CFP: 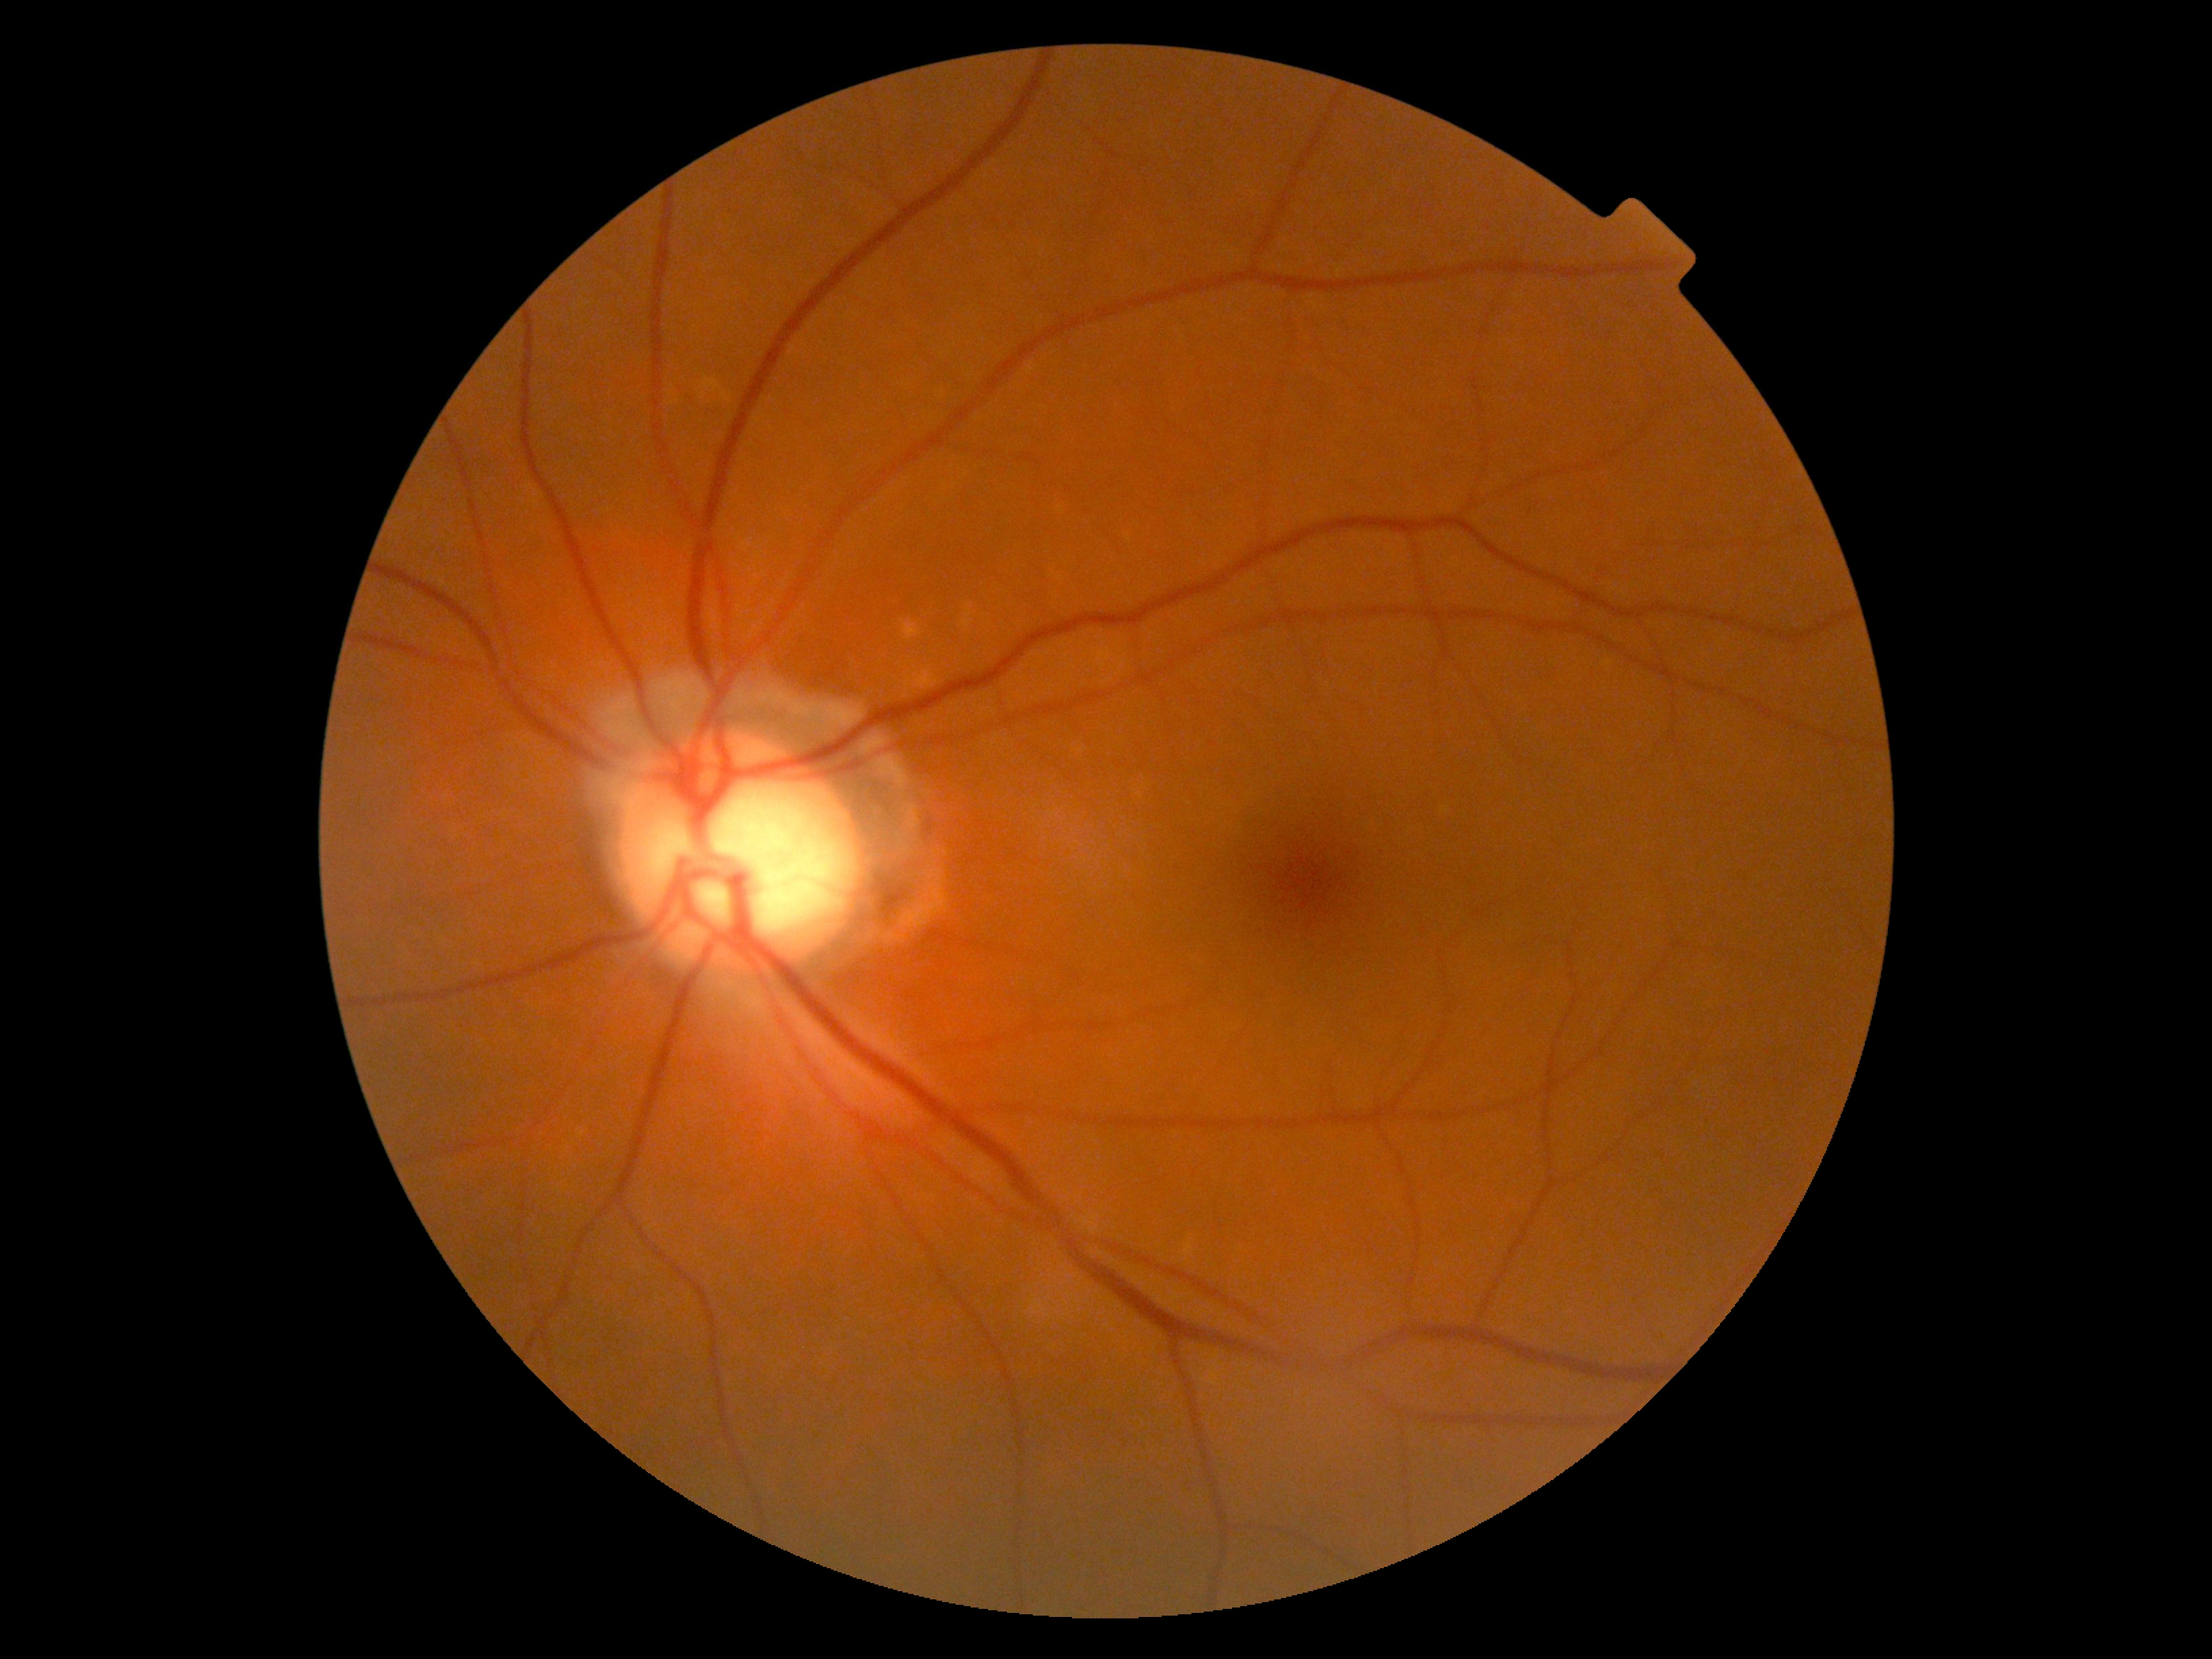

{"dr_grade": "grade 0 (no apparent retinopathy)"}